CFP · FOV: 45 degrees · 2352x1568px: 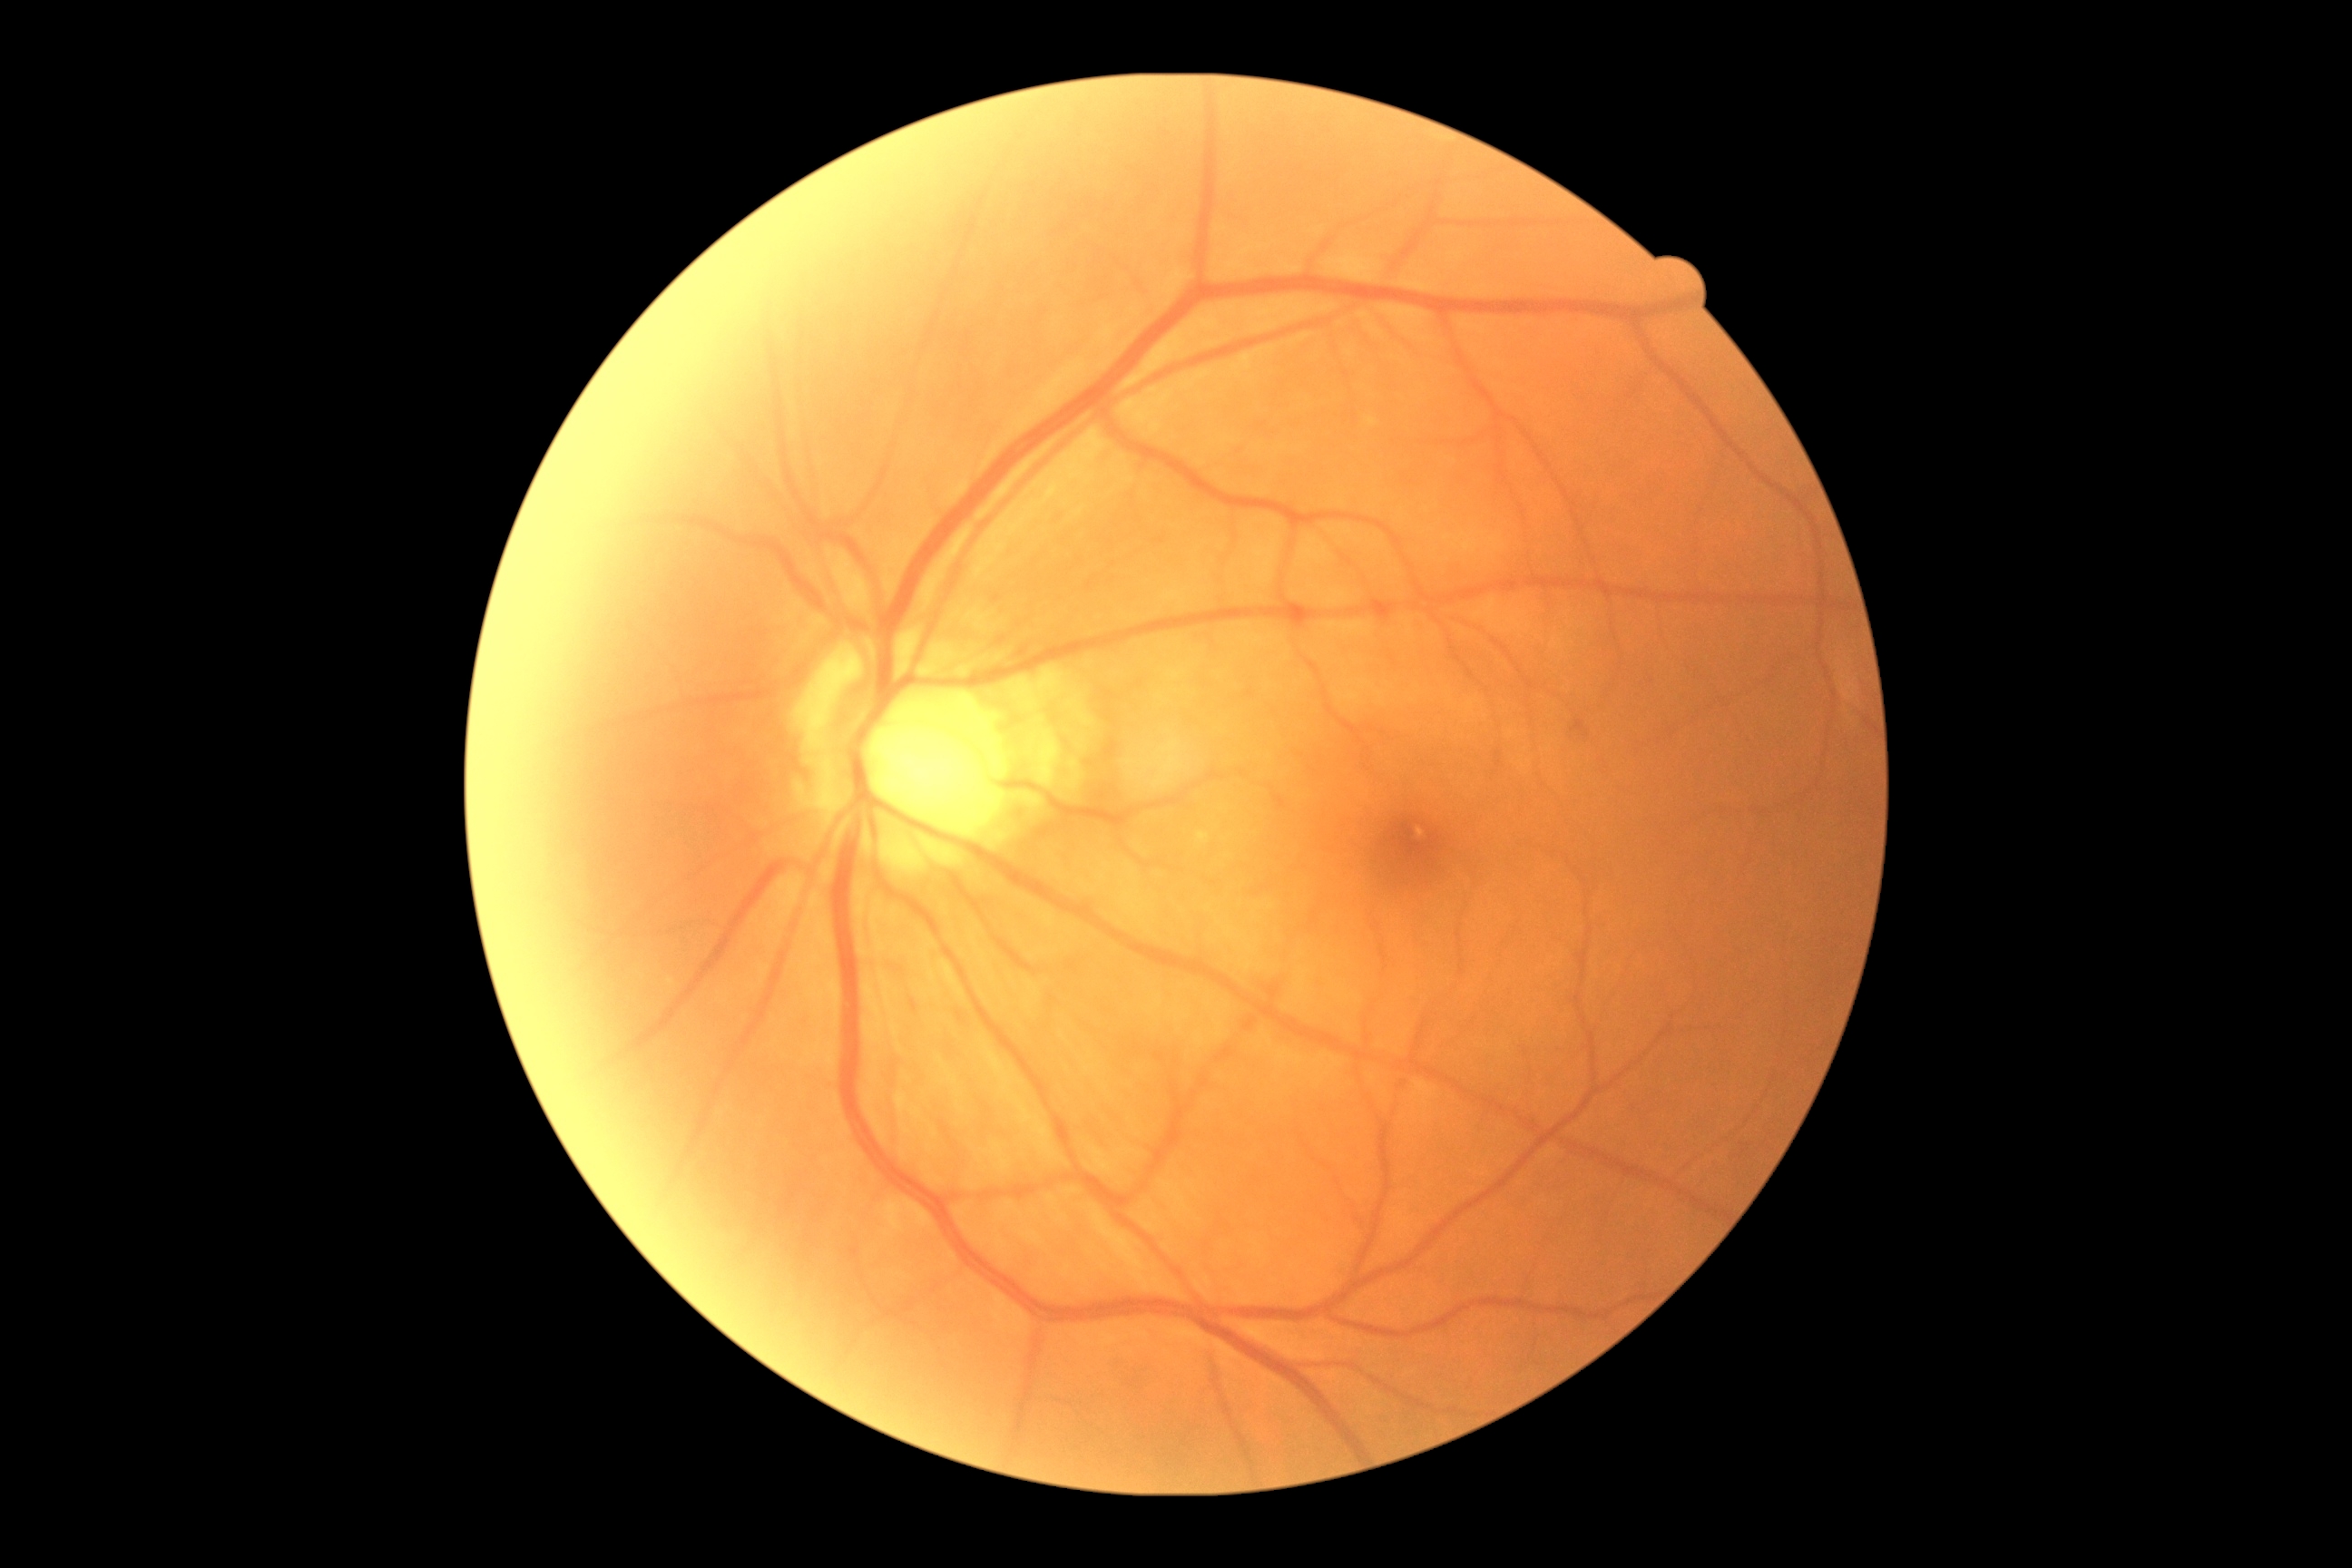

DR severity is grade 0 (no apparent retinopathy).